Acquired with a Topcon TRC-50DX; dilated-pupil acquisition:
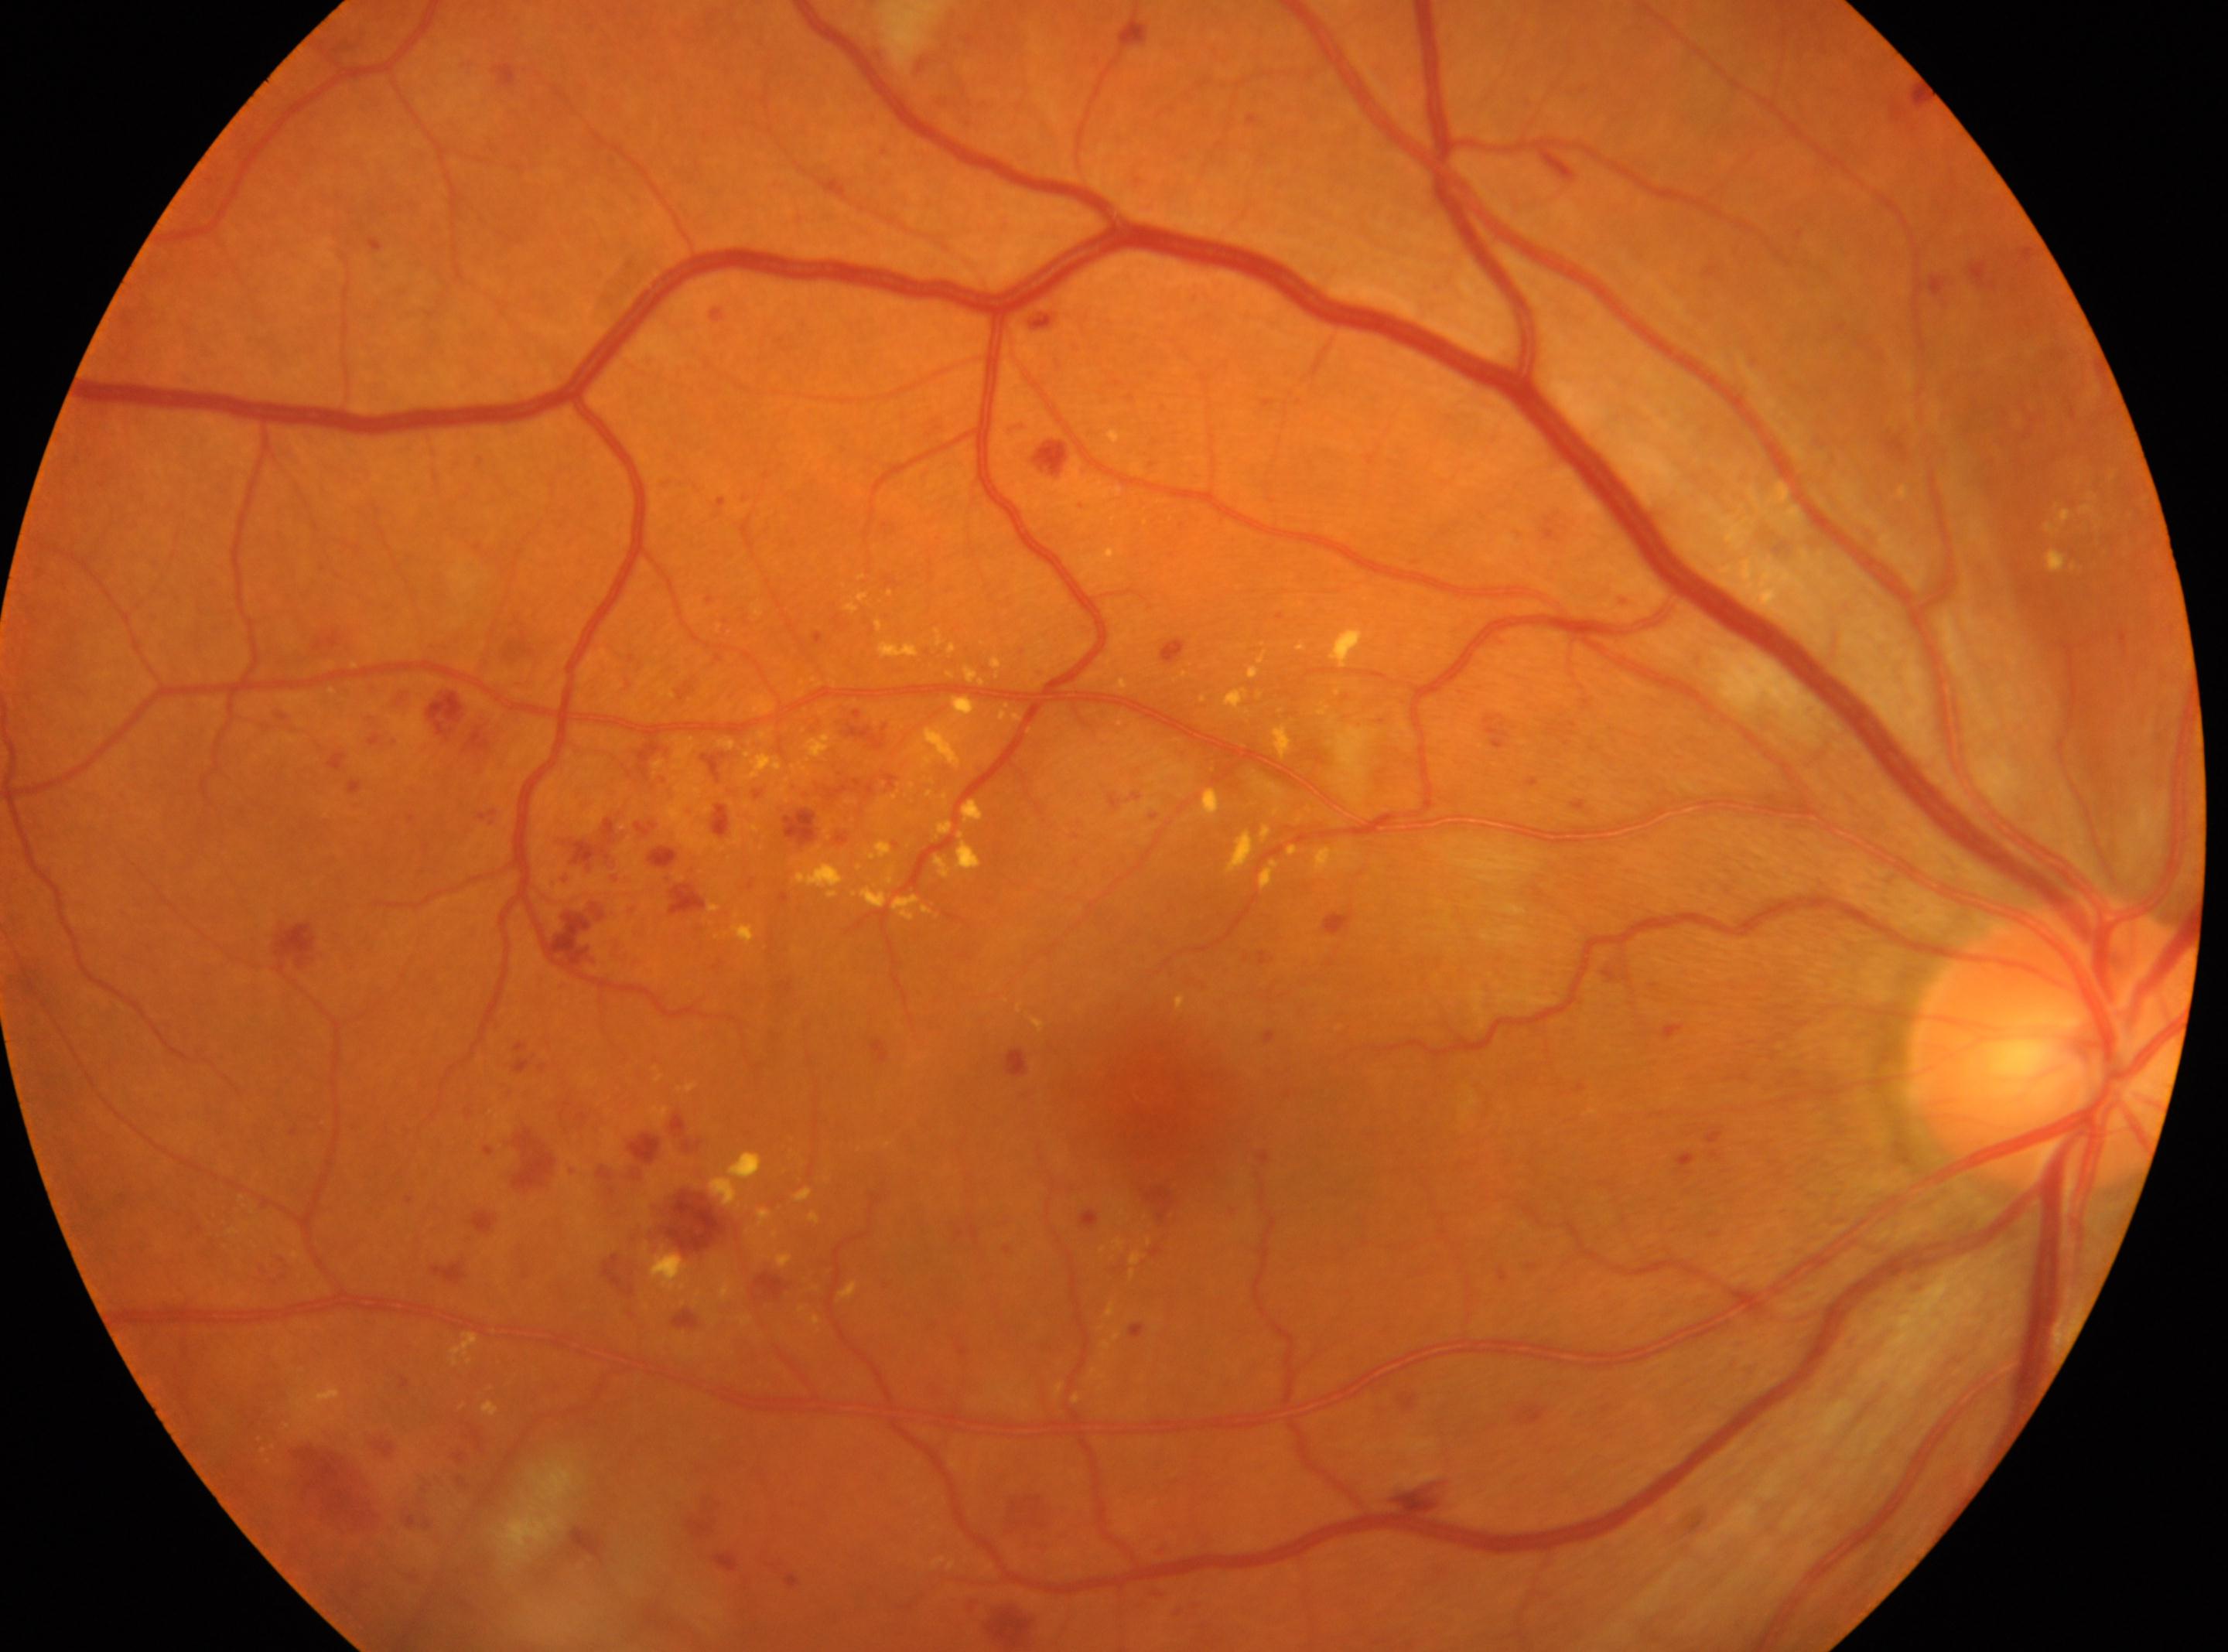 {"dr_grade": "3/4", "fovea": "(1157, 1098)", "eye": "the right eye", "optic_disc": "(2054, 1042)"}